Retinal fundus photograph. 1659x2212px — 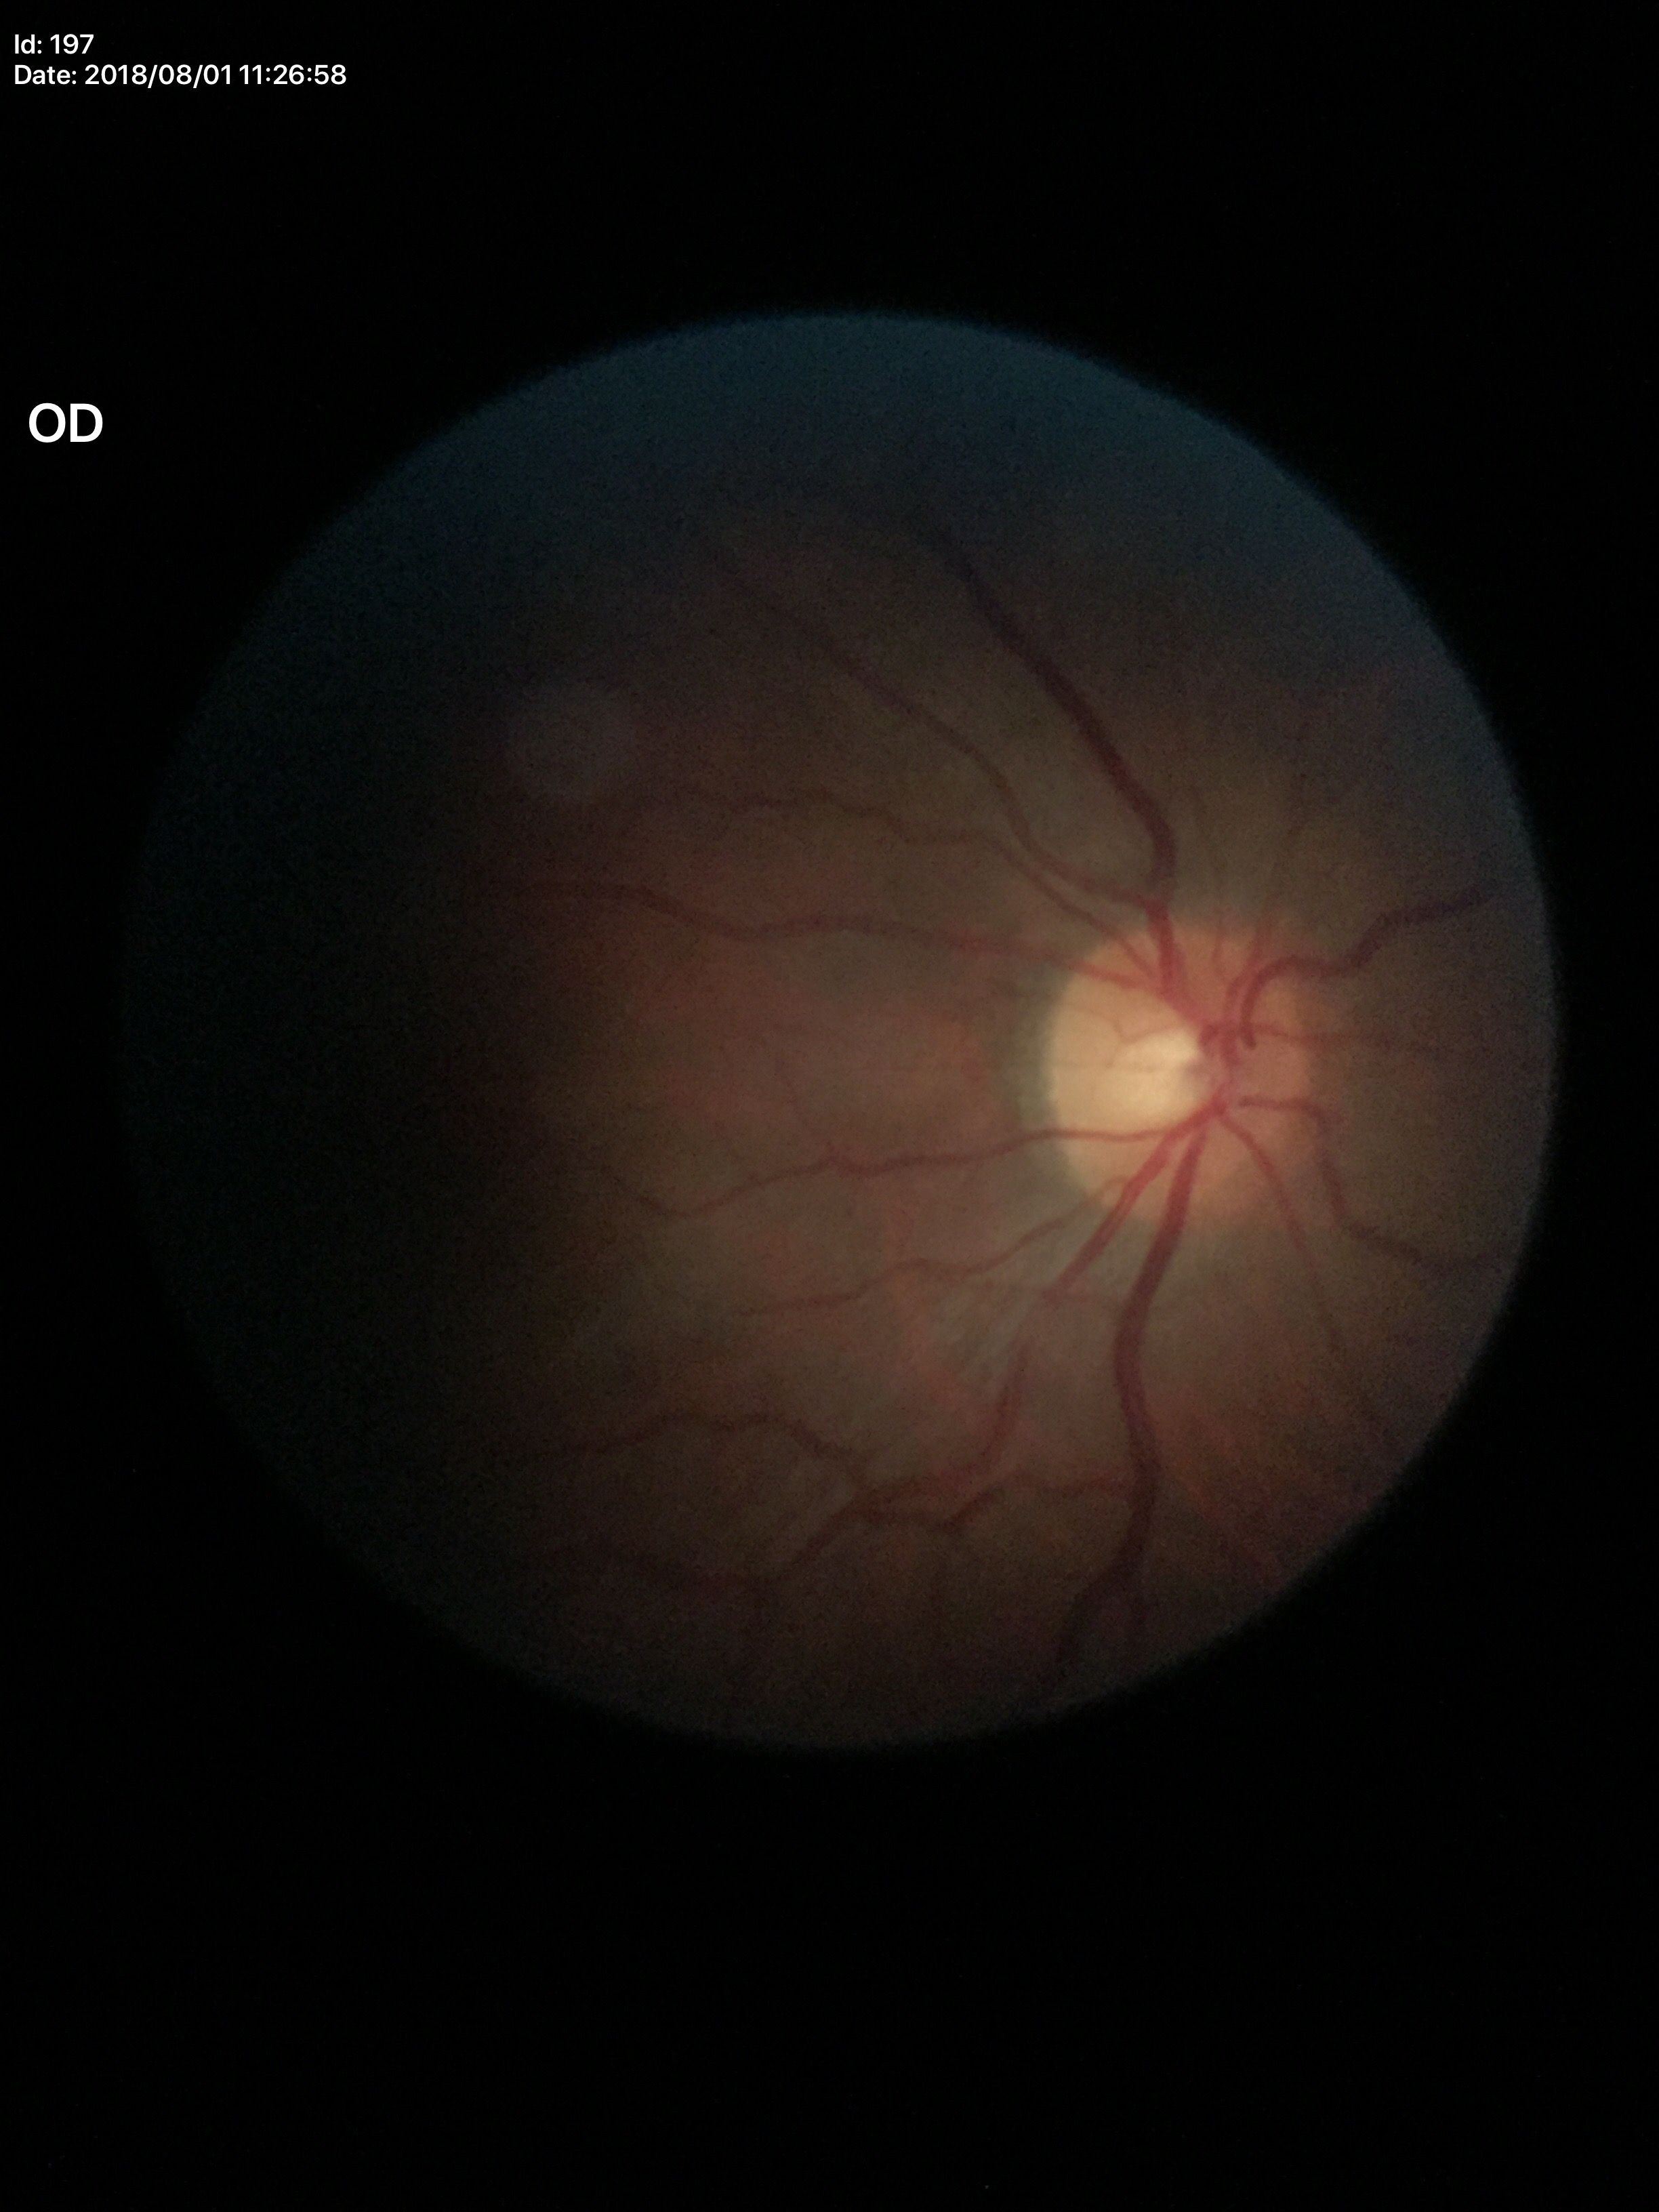

Glaucoma evaluation: negative (1/5 graders called glaucoma suspect)
vertical cup-to-disc ratio (VCDR): 0.51